Fundus photograph cropped around the optic nerve head.
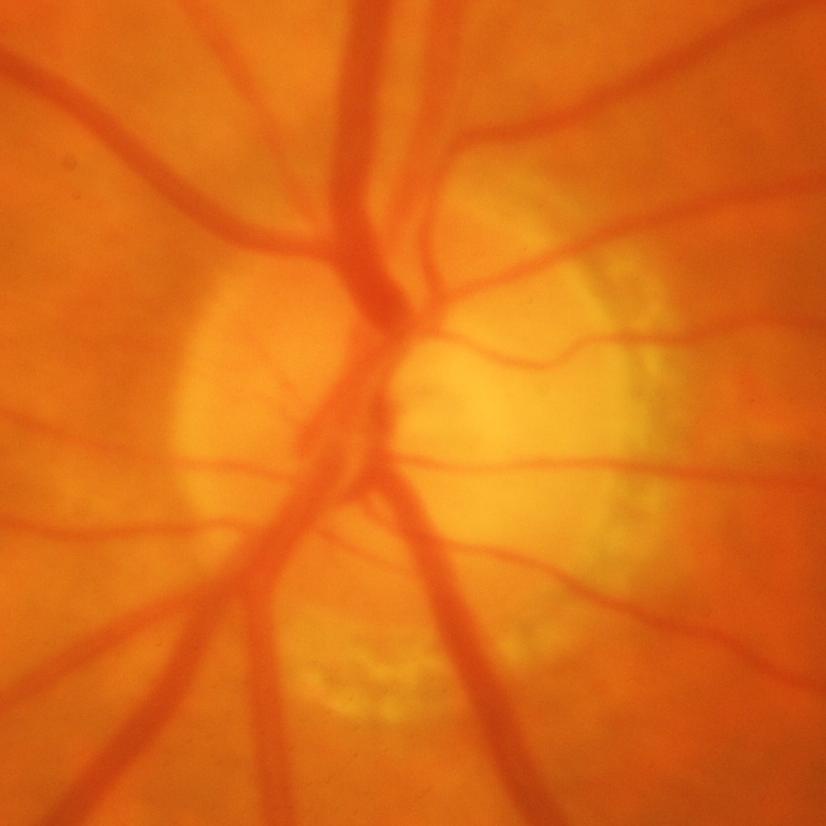
Glaucomatous optic neuropathy is present. Optic disc appearance consistent with glaucomatous findings.